Graded on the modified Davis scale: 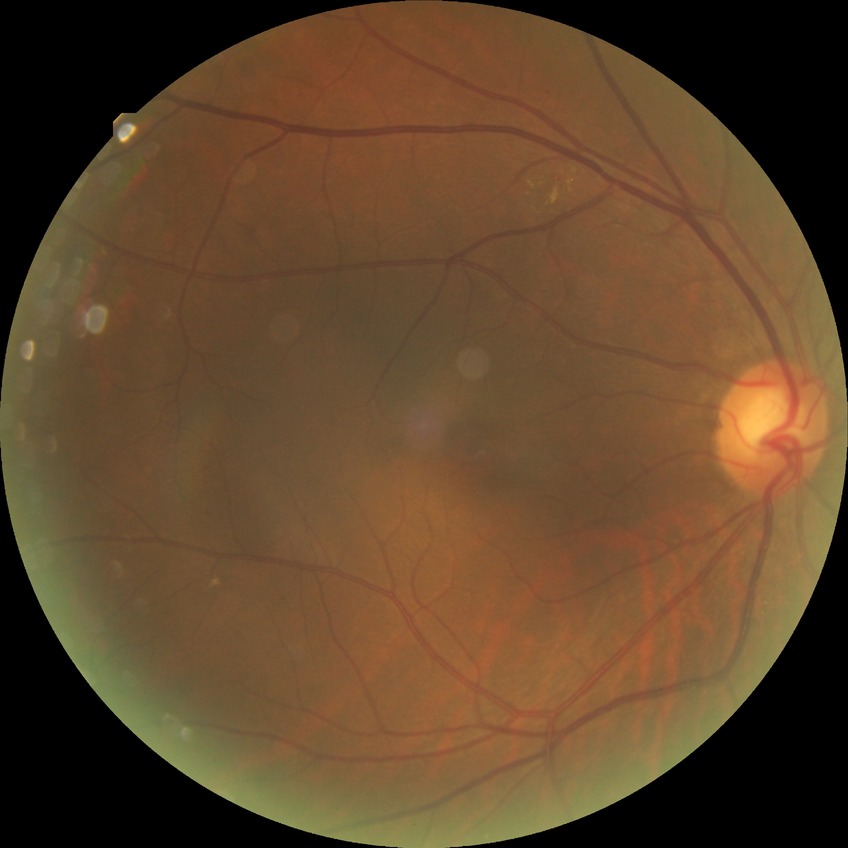

{
  "davis_grade": "simple diabetic retinopathy",
  "proliferative_class": "non-proliferative diabetic retinopathy"
}